CFP — 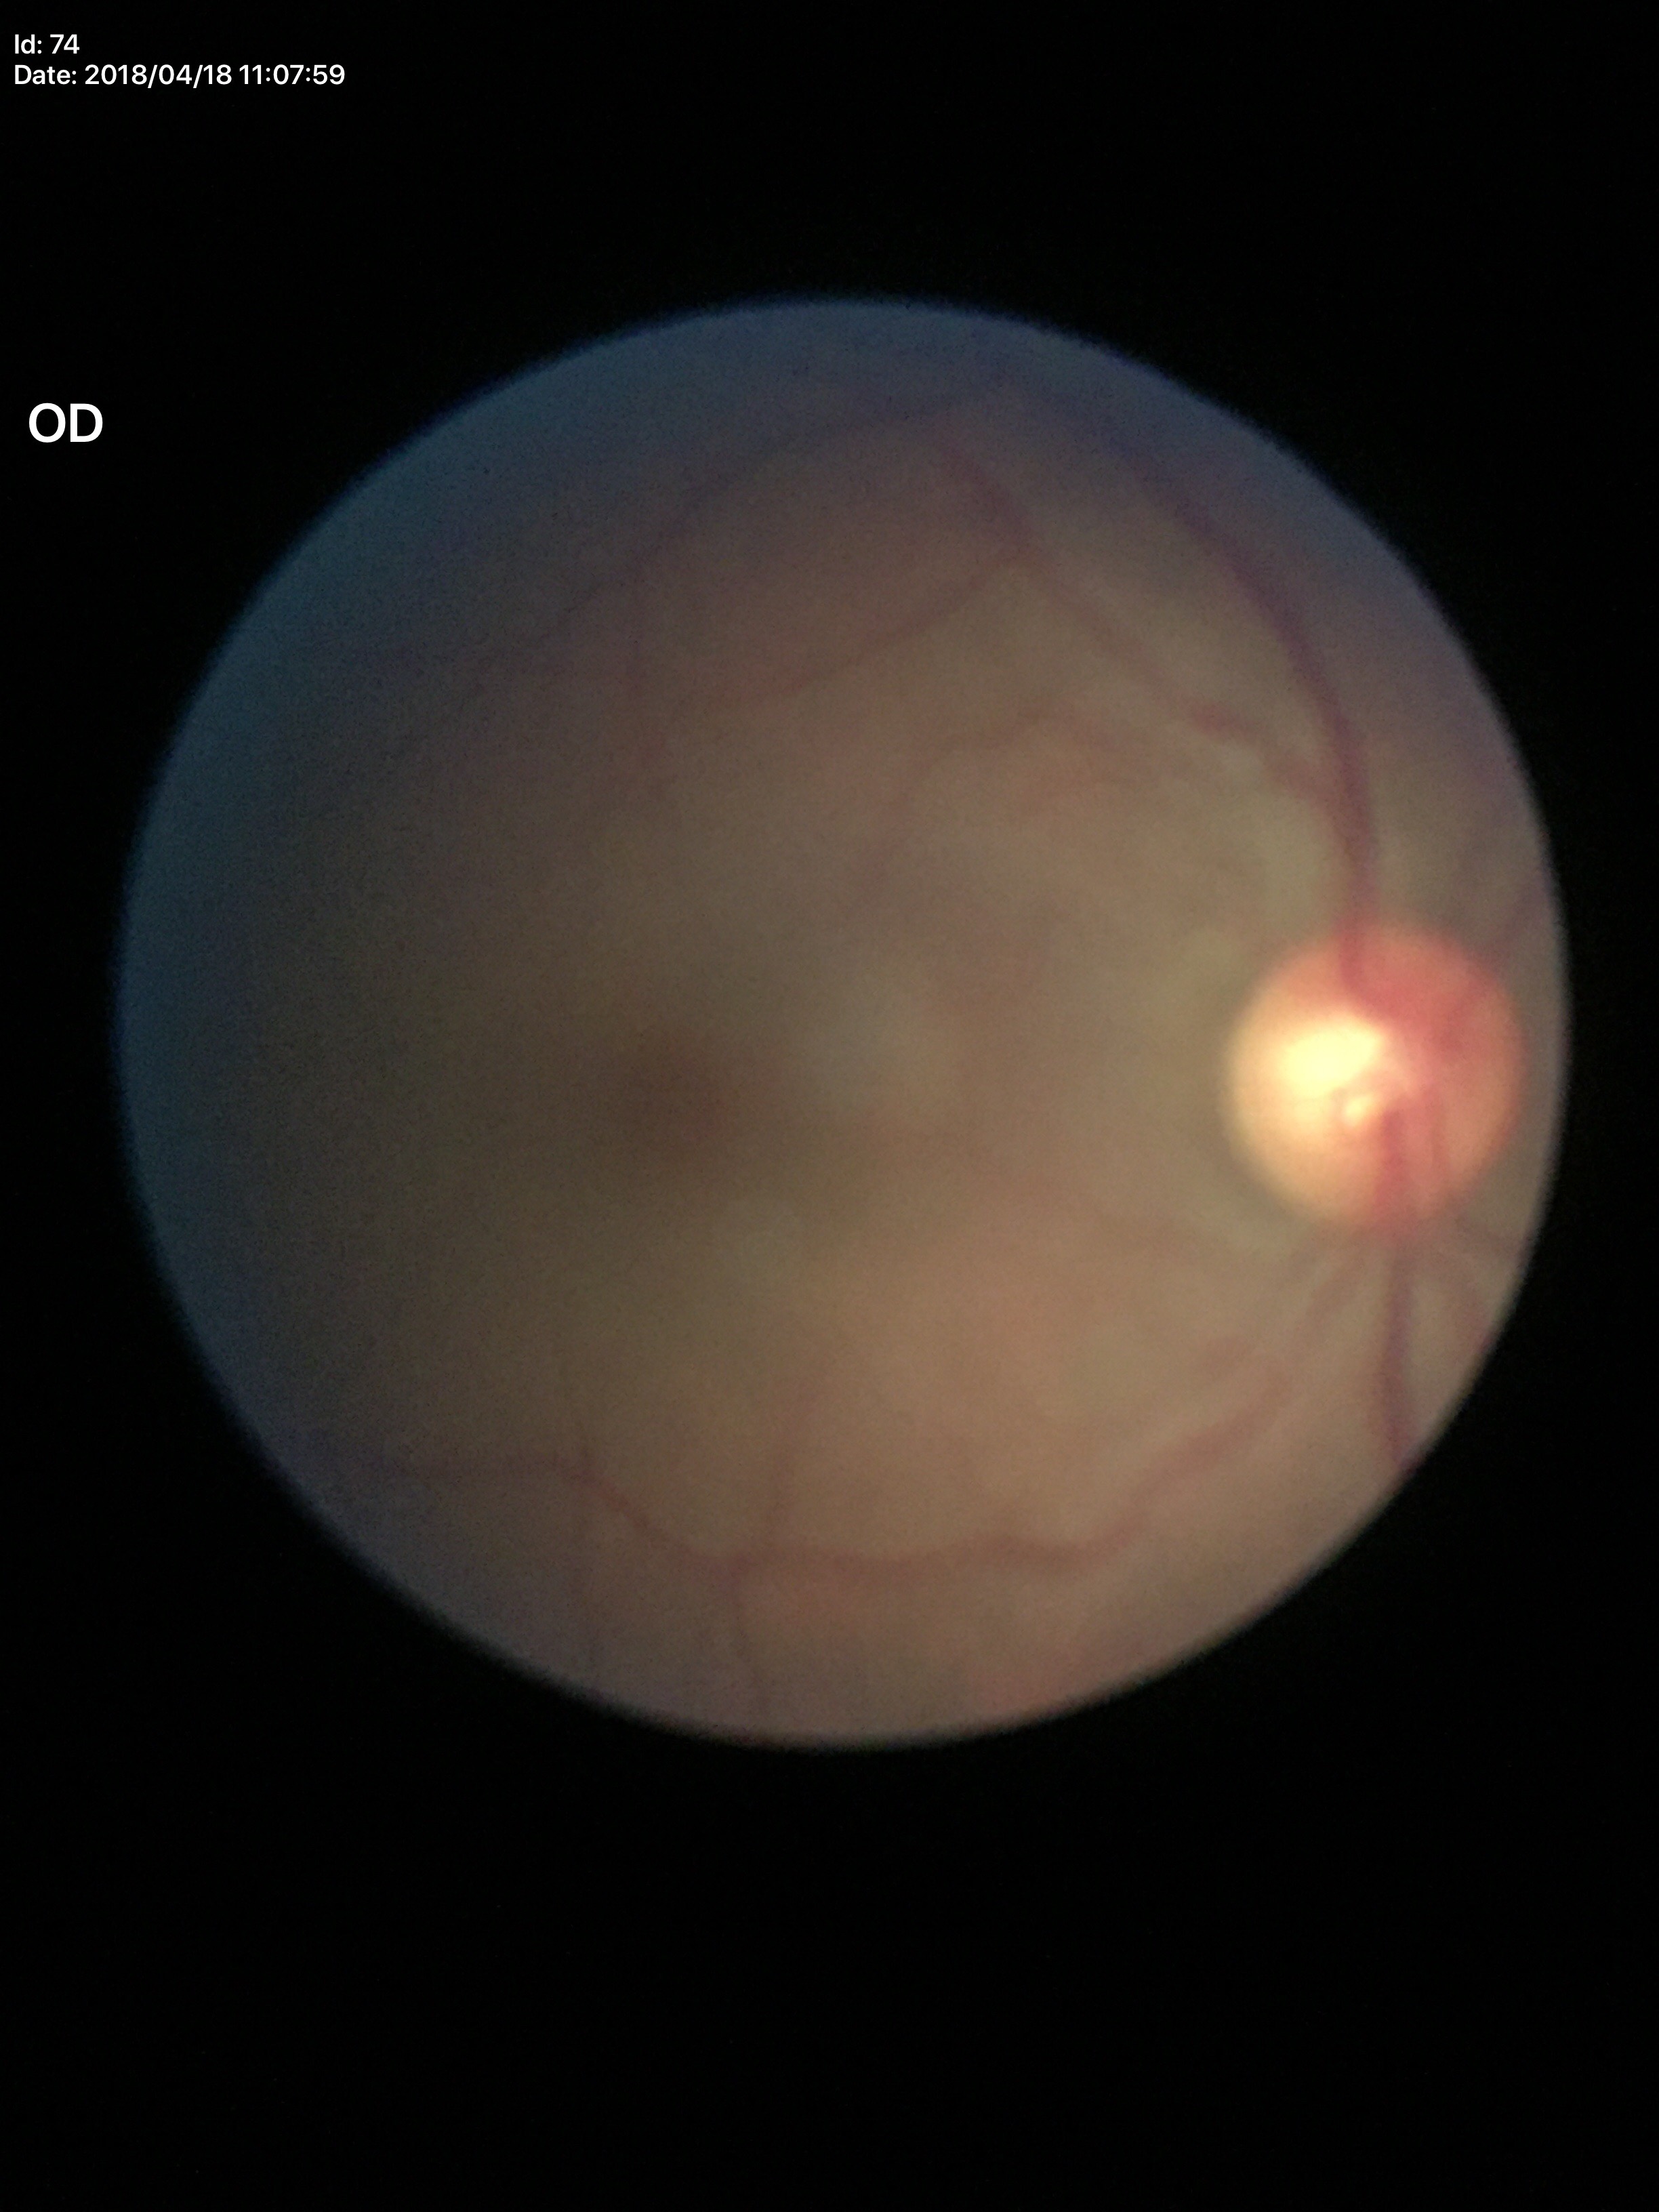 Vertical cup-to-disc ratio (VCDR): 0.52.
No evidence of glaucoma (5/5 ophthalmologists in agreement).